Color fundus photograph, 45-degree field of view.
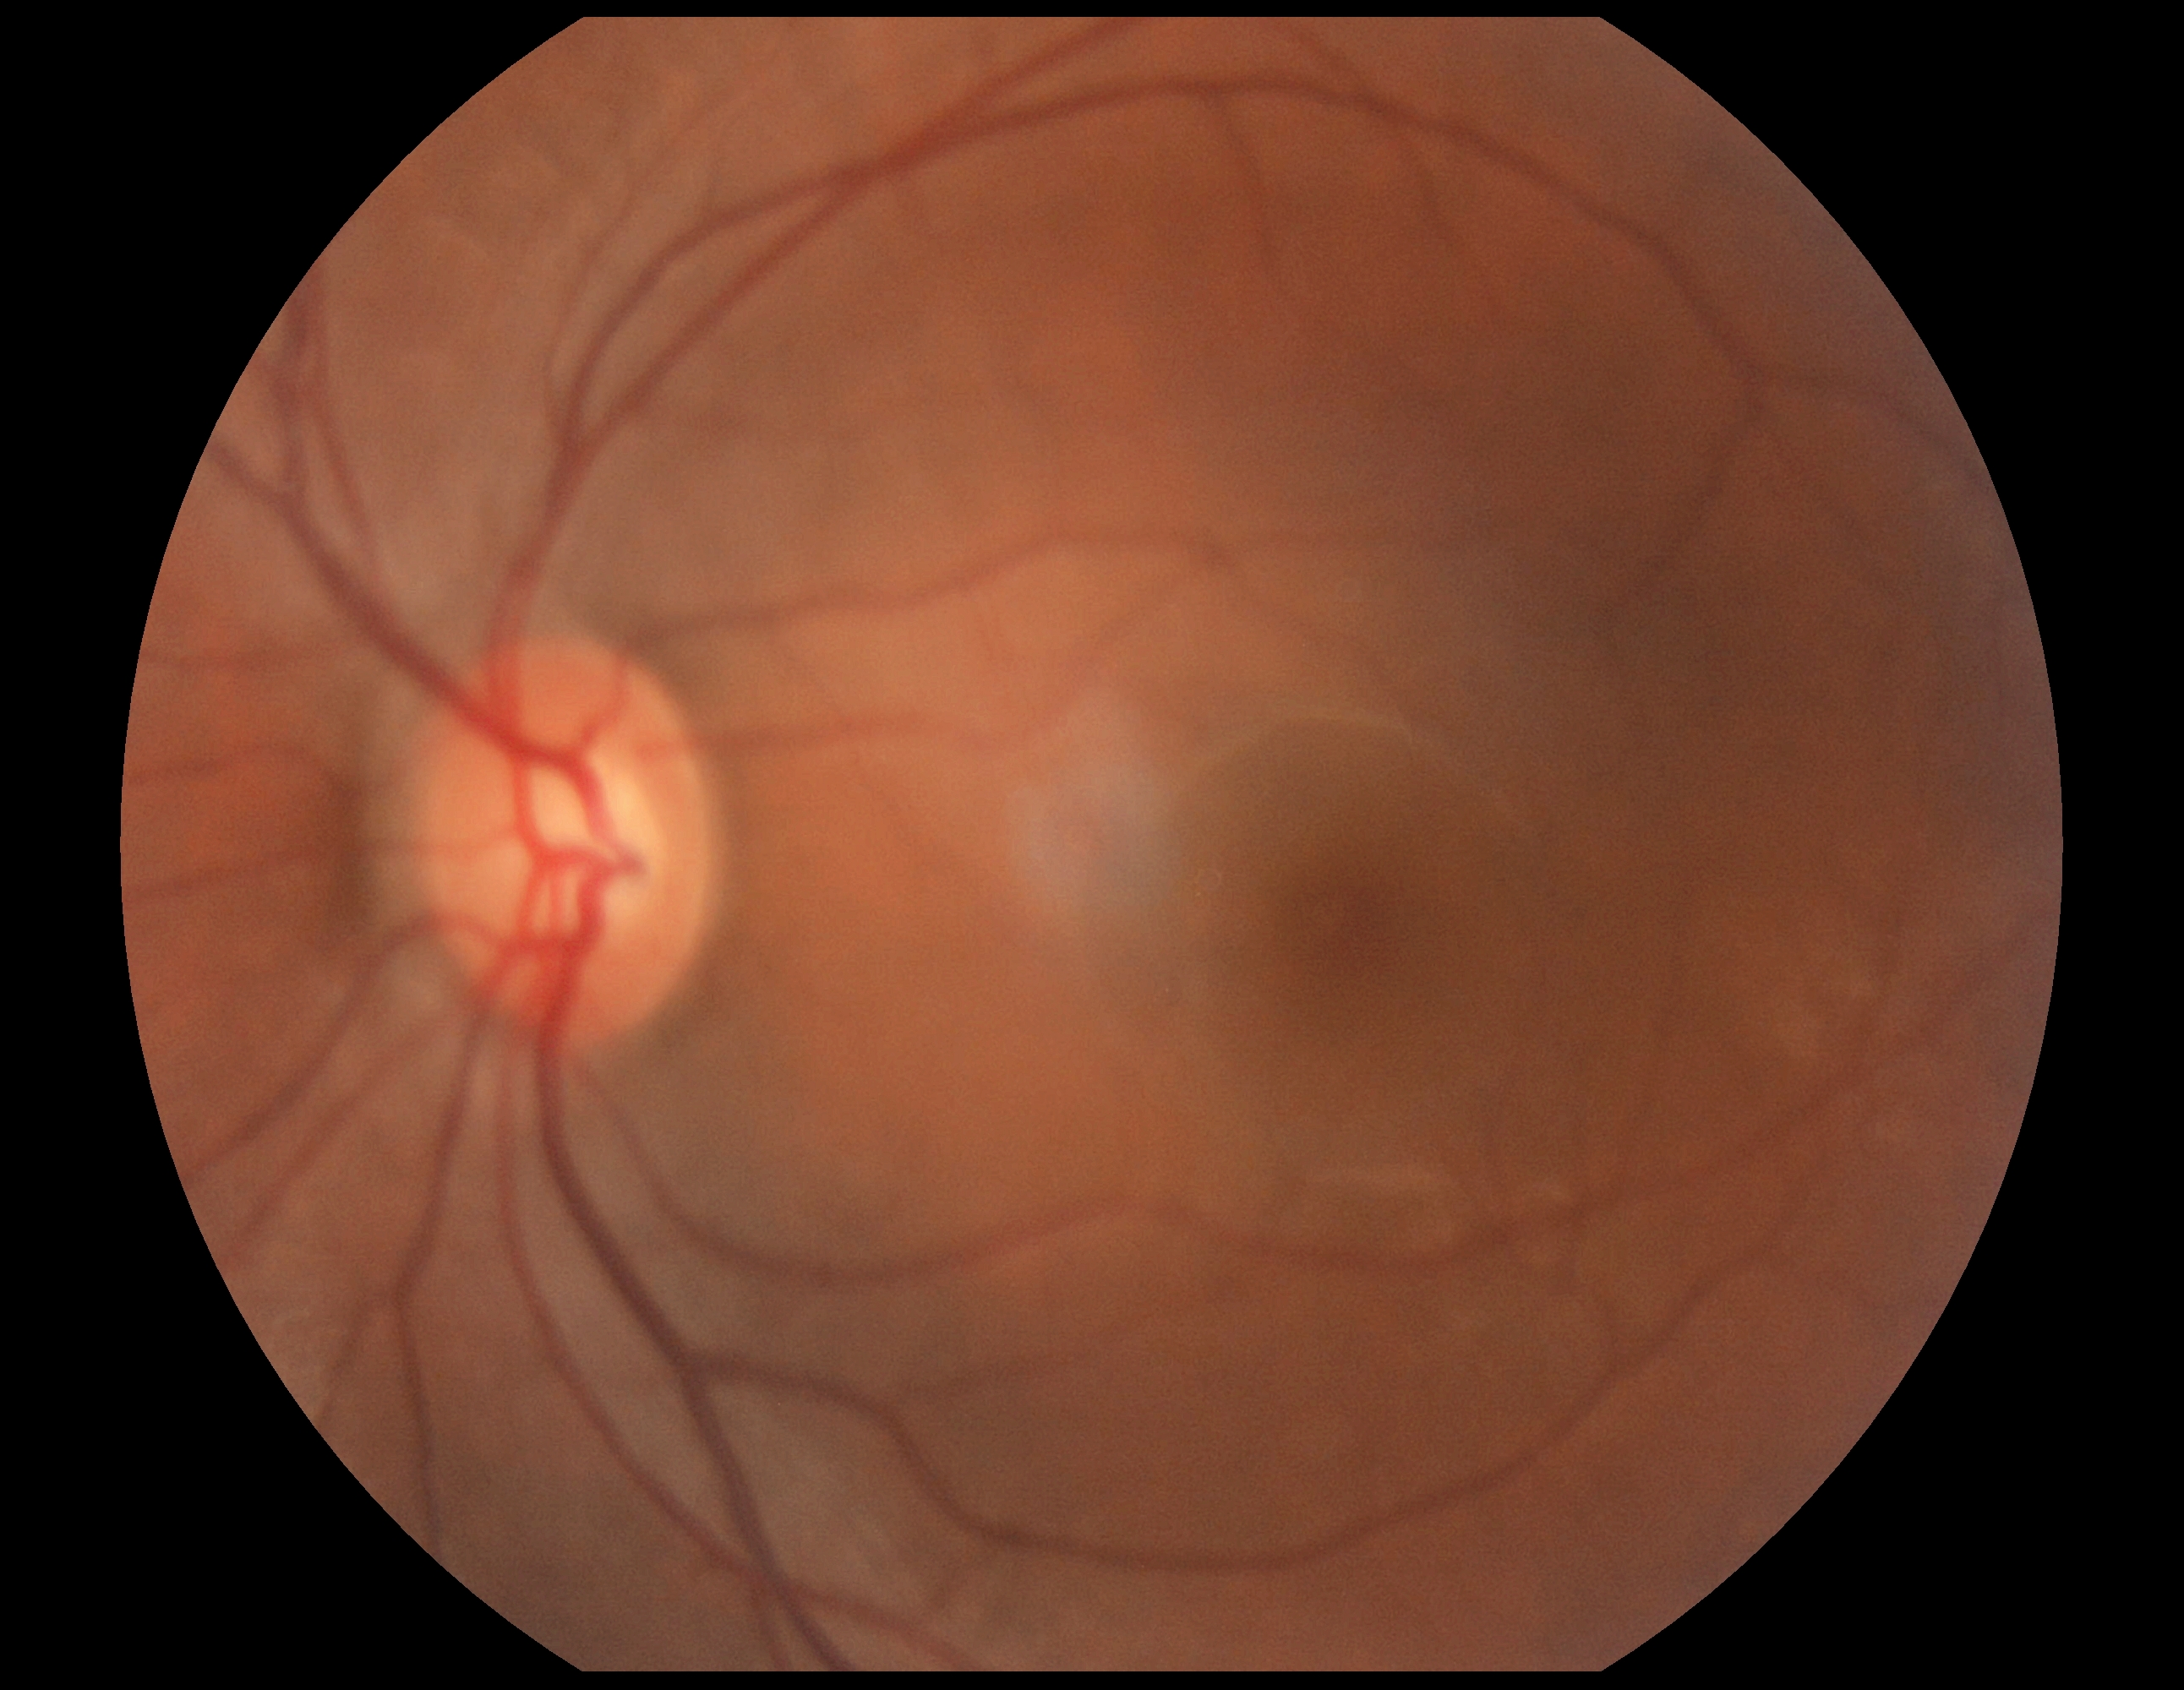
diabetic retinopathy severity = grade 0 (no apparent retinopathy) — no visible signs of diabetic retinopathy.